Clarity RetCam 3, 130° FOV; wide-field fundus photograph from neonatal ROP screening.
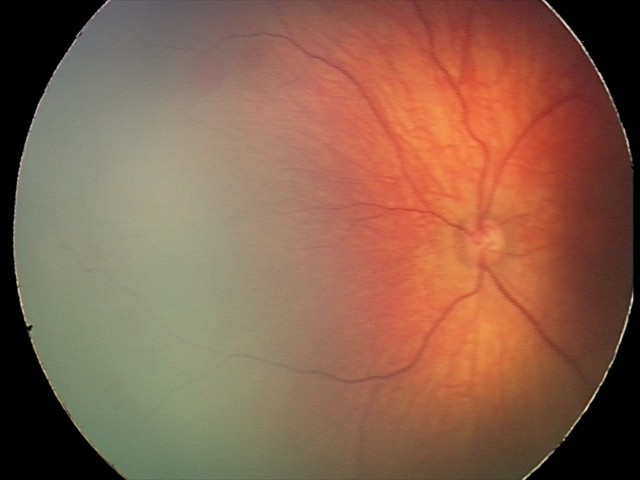

Impression: retinal hemorrhages.